2048x1536 · retinal fundus photograph — 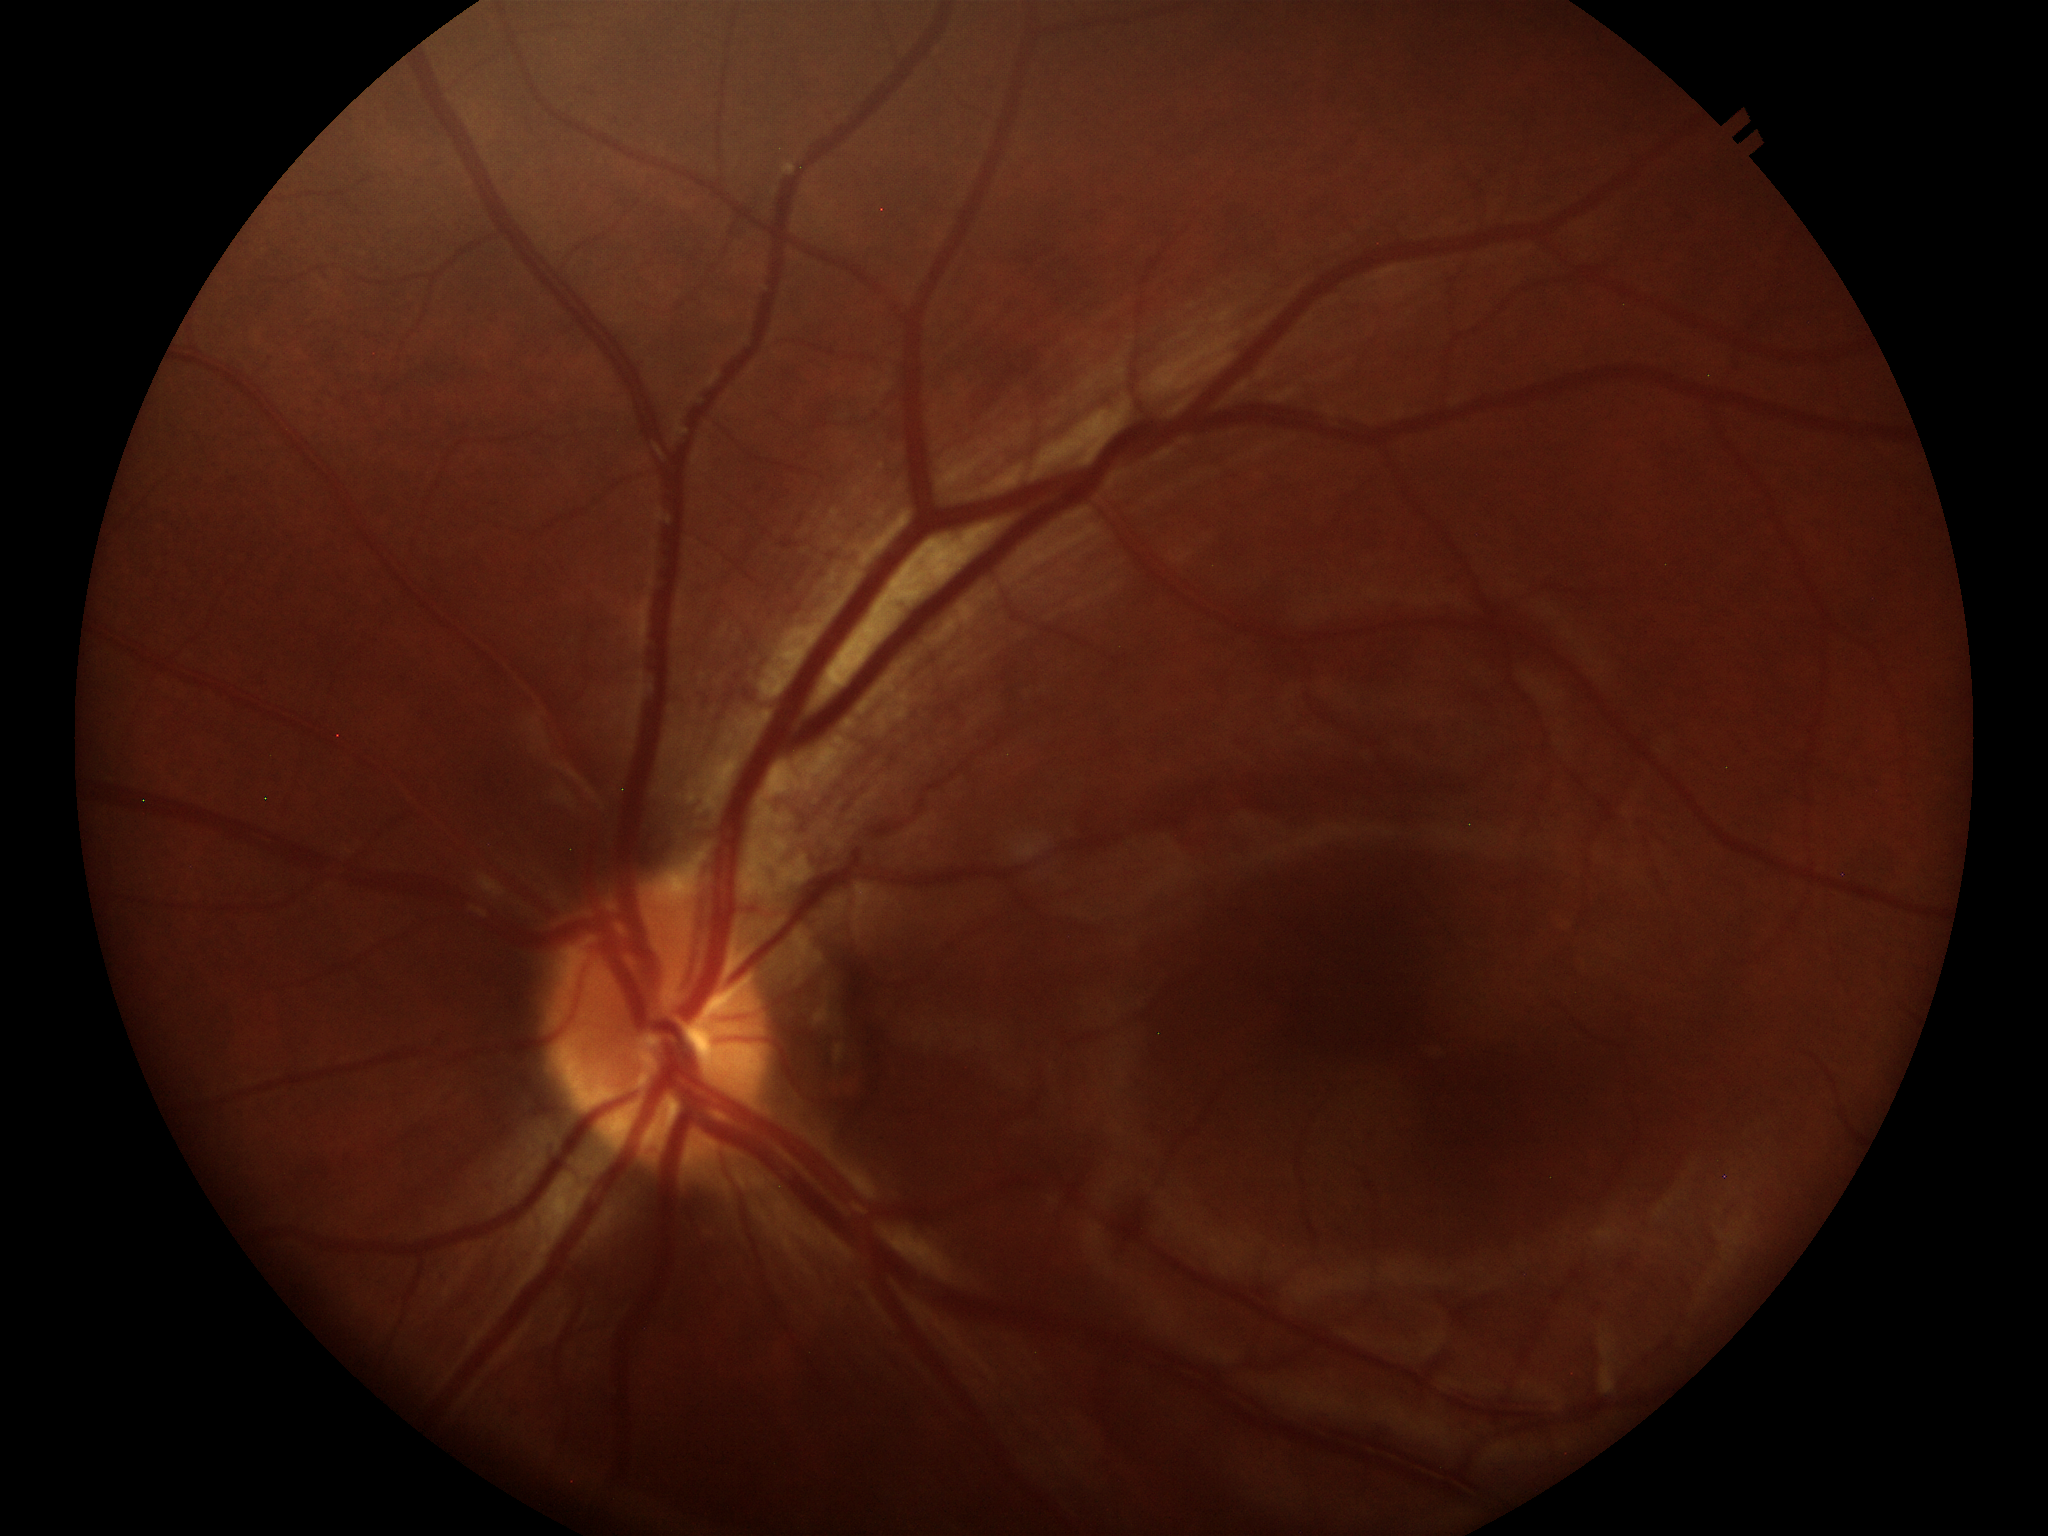

No glaucomatous optic neuropathy (all 5 graders called normal). Vertical cup-disc ratio (VCDR): 0.28. Area cup-disc ratio (ACDR): 0.09. Horizontal cup-to-disc ratio (HCDR) of 0.36.